1932x1910:
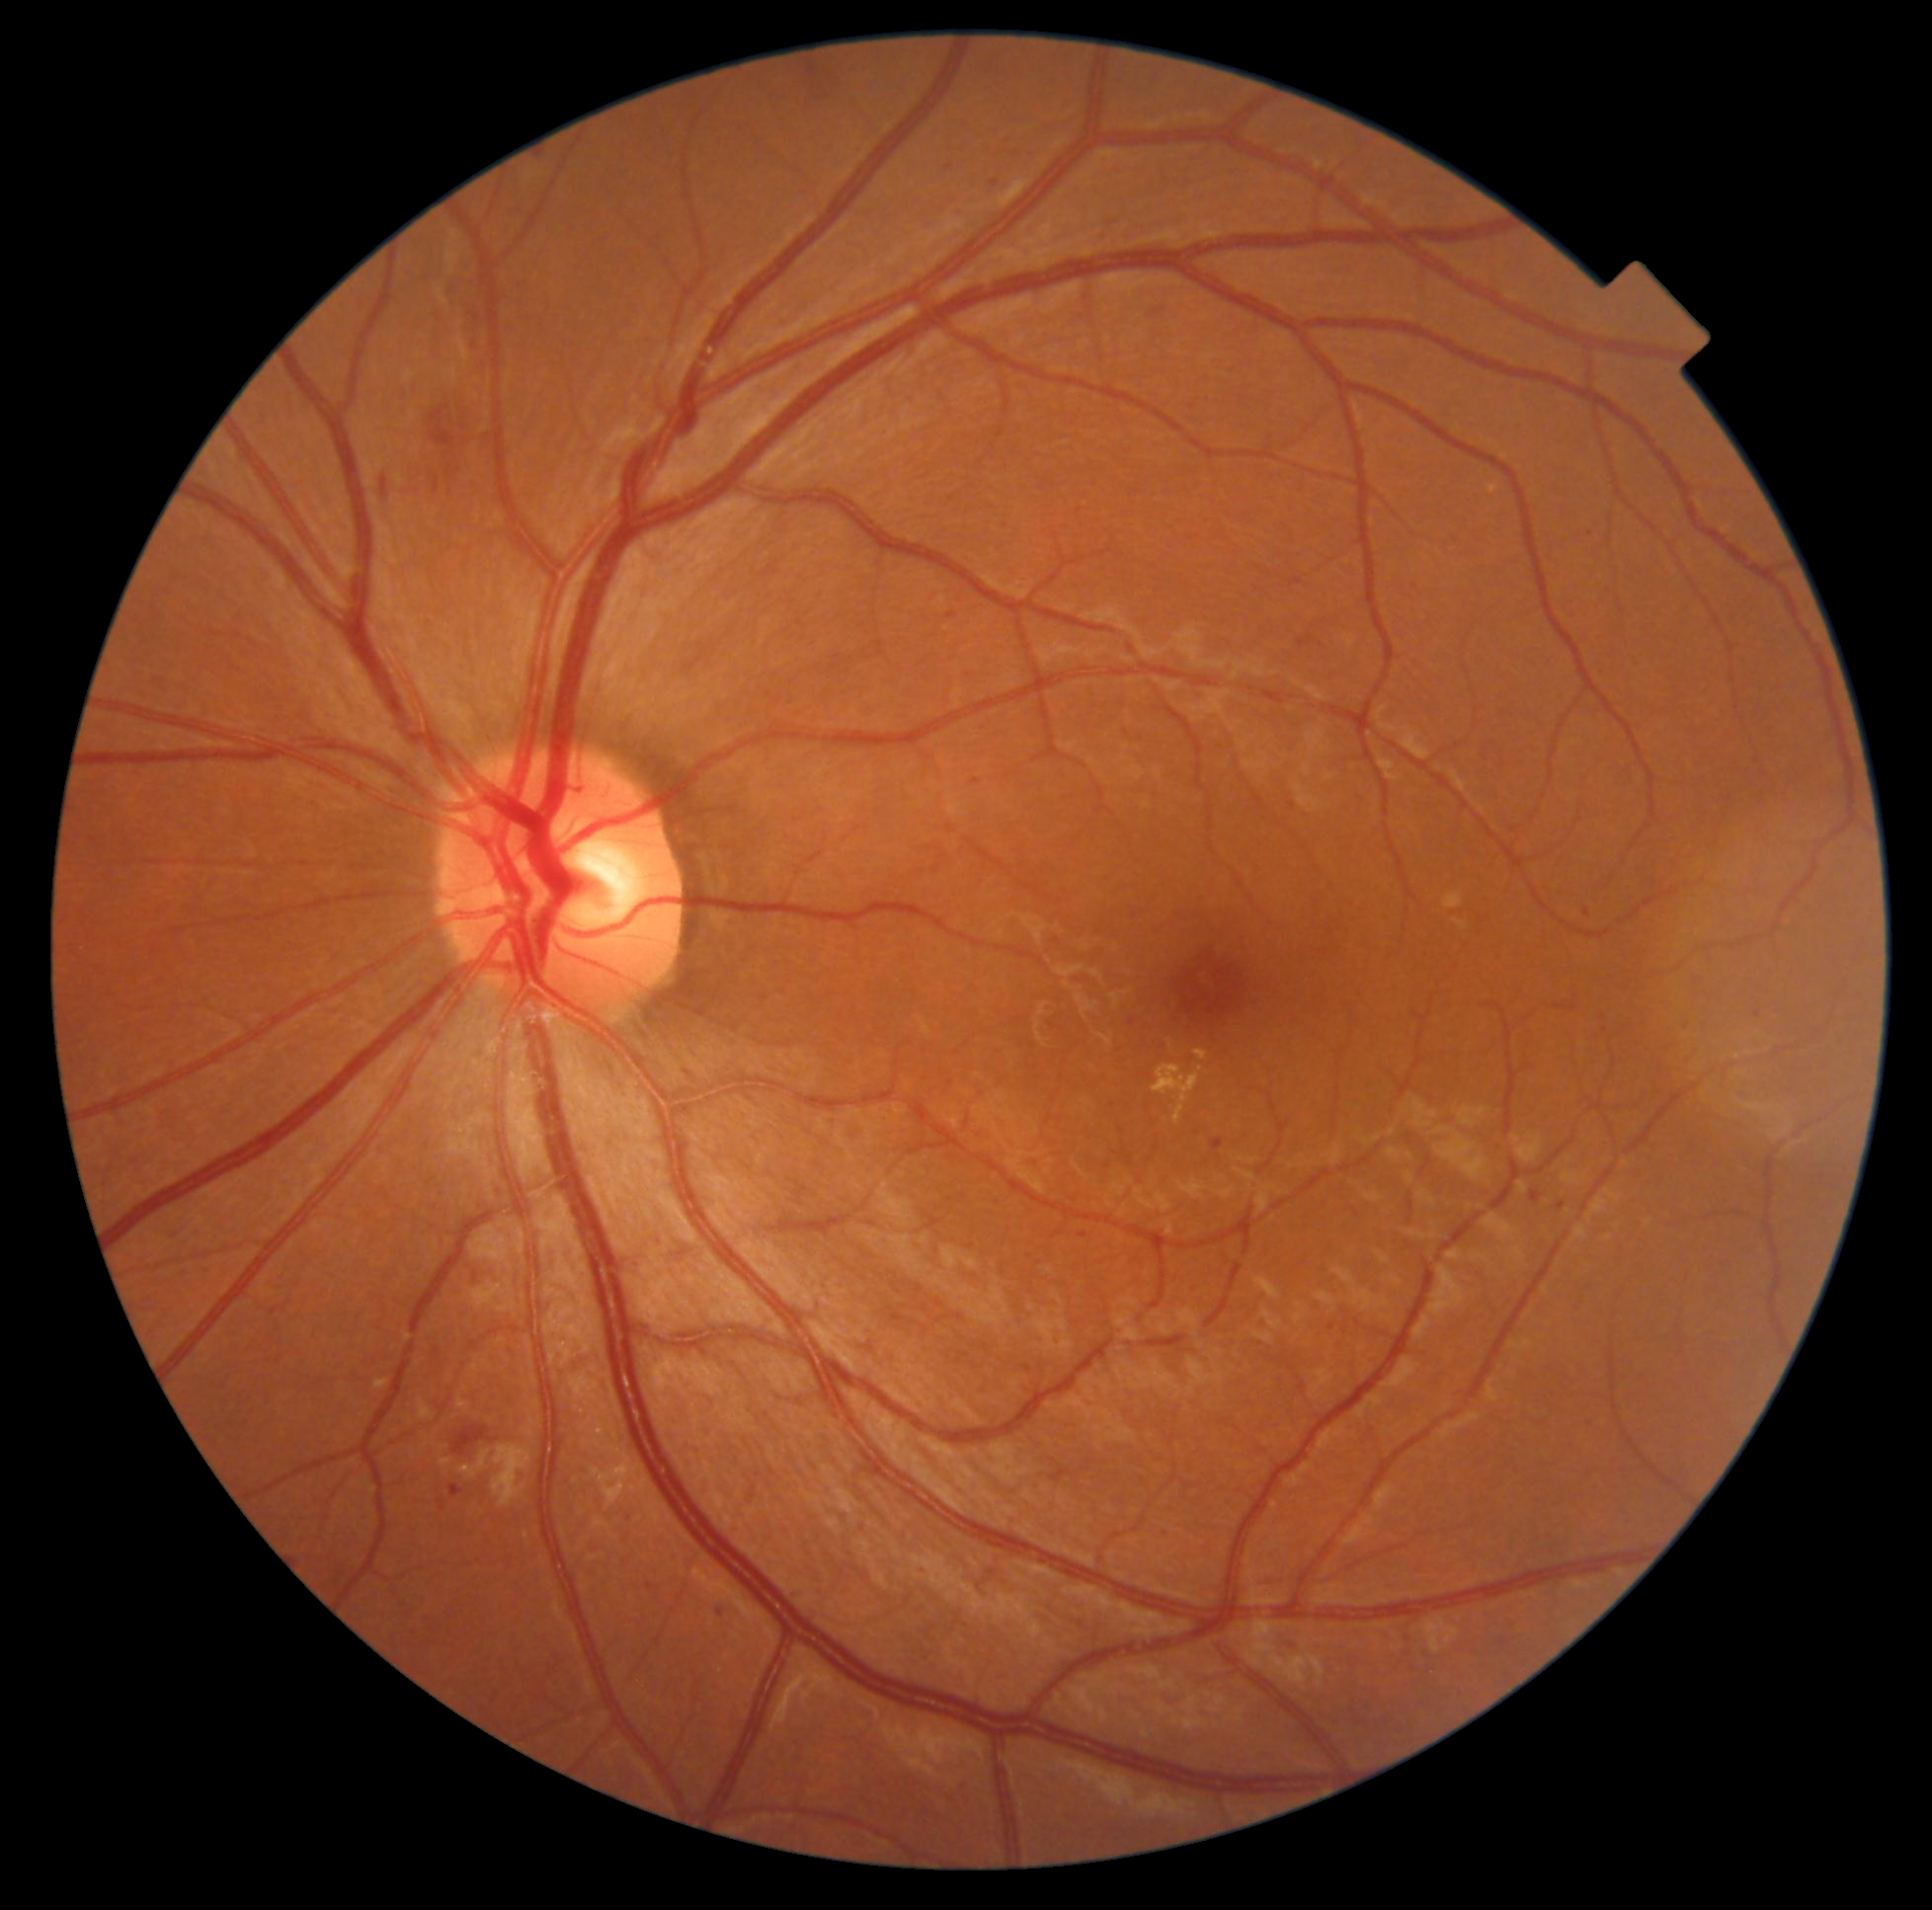
<lesions partial="true">
  <dr_grade>2</dr_grade>
  <ma partial="true">719,1606,724,1617 | 1558,1202,1567,1211 | 1036,1261,1044,1266 | 1284,1641,1297,1649 | 945,166,954,171 | 1531,1191,1541,1204</ma>
  <ma_small_approx>pt(1757, 1014) | pt(798, 1597) | pt(1132, 1023) | pt(1085, 1236) | pt(1029, 1370) | pt(650, 1587)</ma_small_approx>
</lesions>